Retinal fundus photograph. Centered on the optic disc
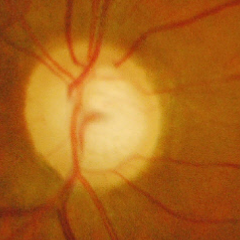
Glaucomatous optic neuropathy is present.
Advanced glaucomatous optic neuropathy.